NIDEK AFC-230. Color fundus photograph. 45 degree fundus photograph
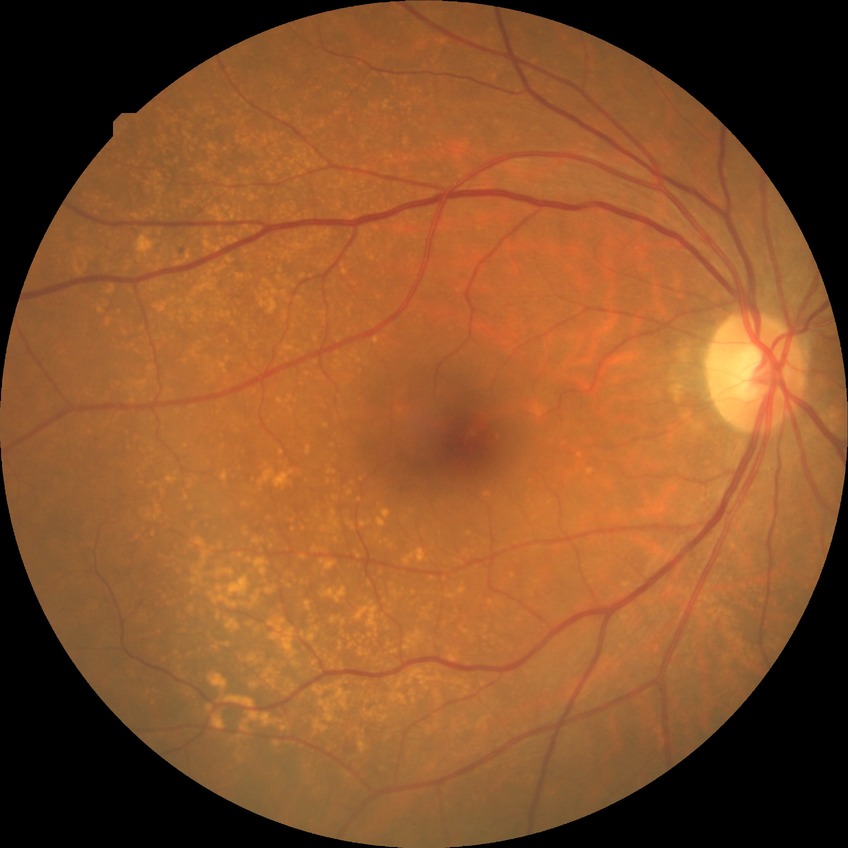 Diabetic retinopathy (DR) is no diabetic retinopathy (NDR).